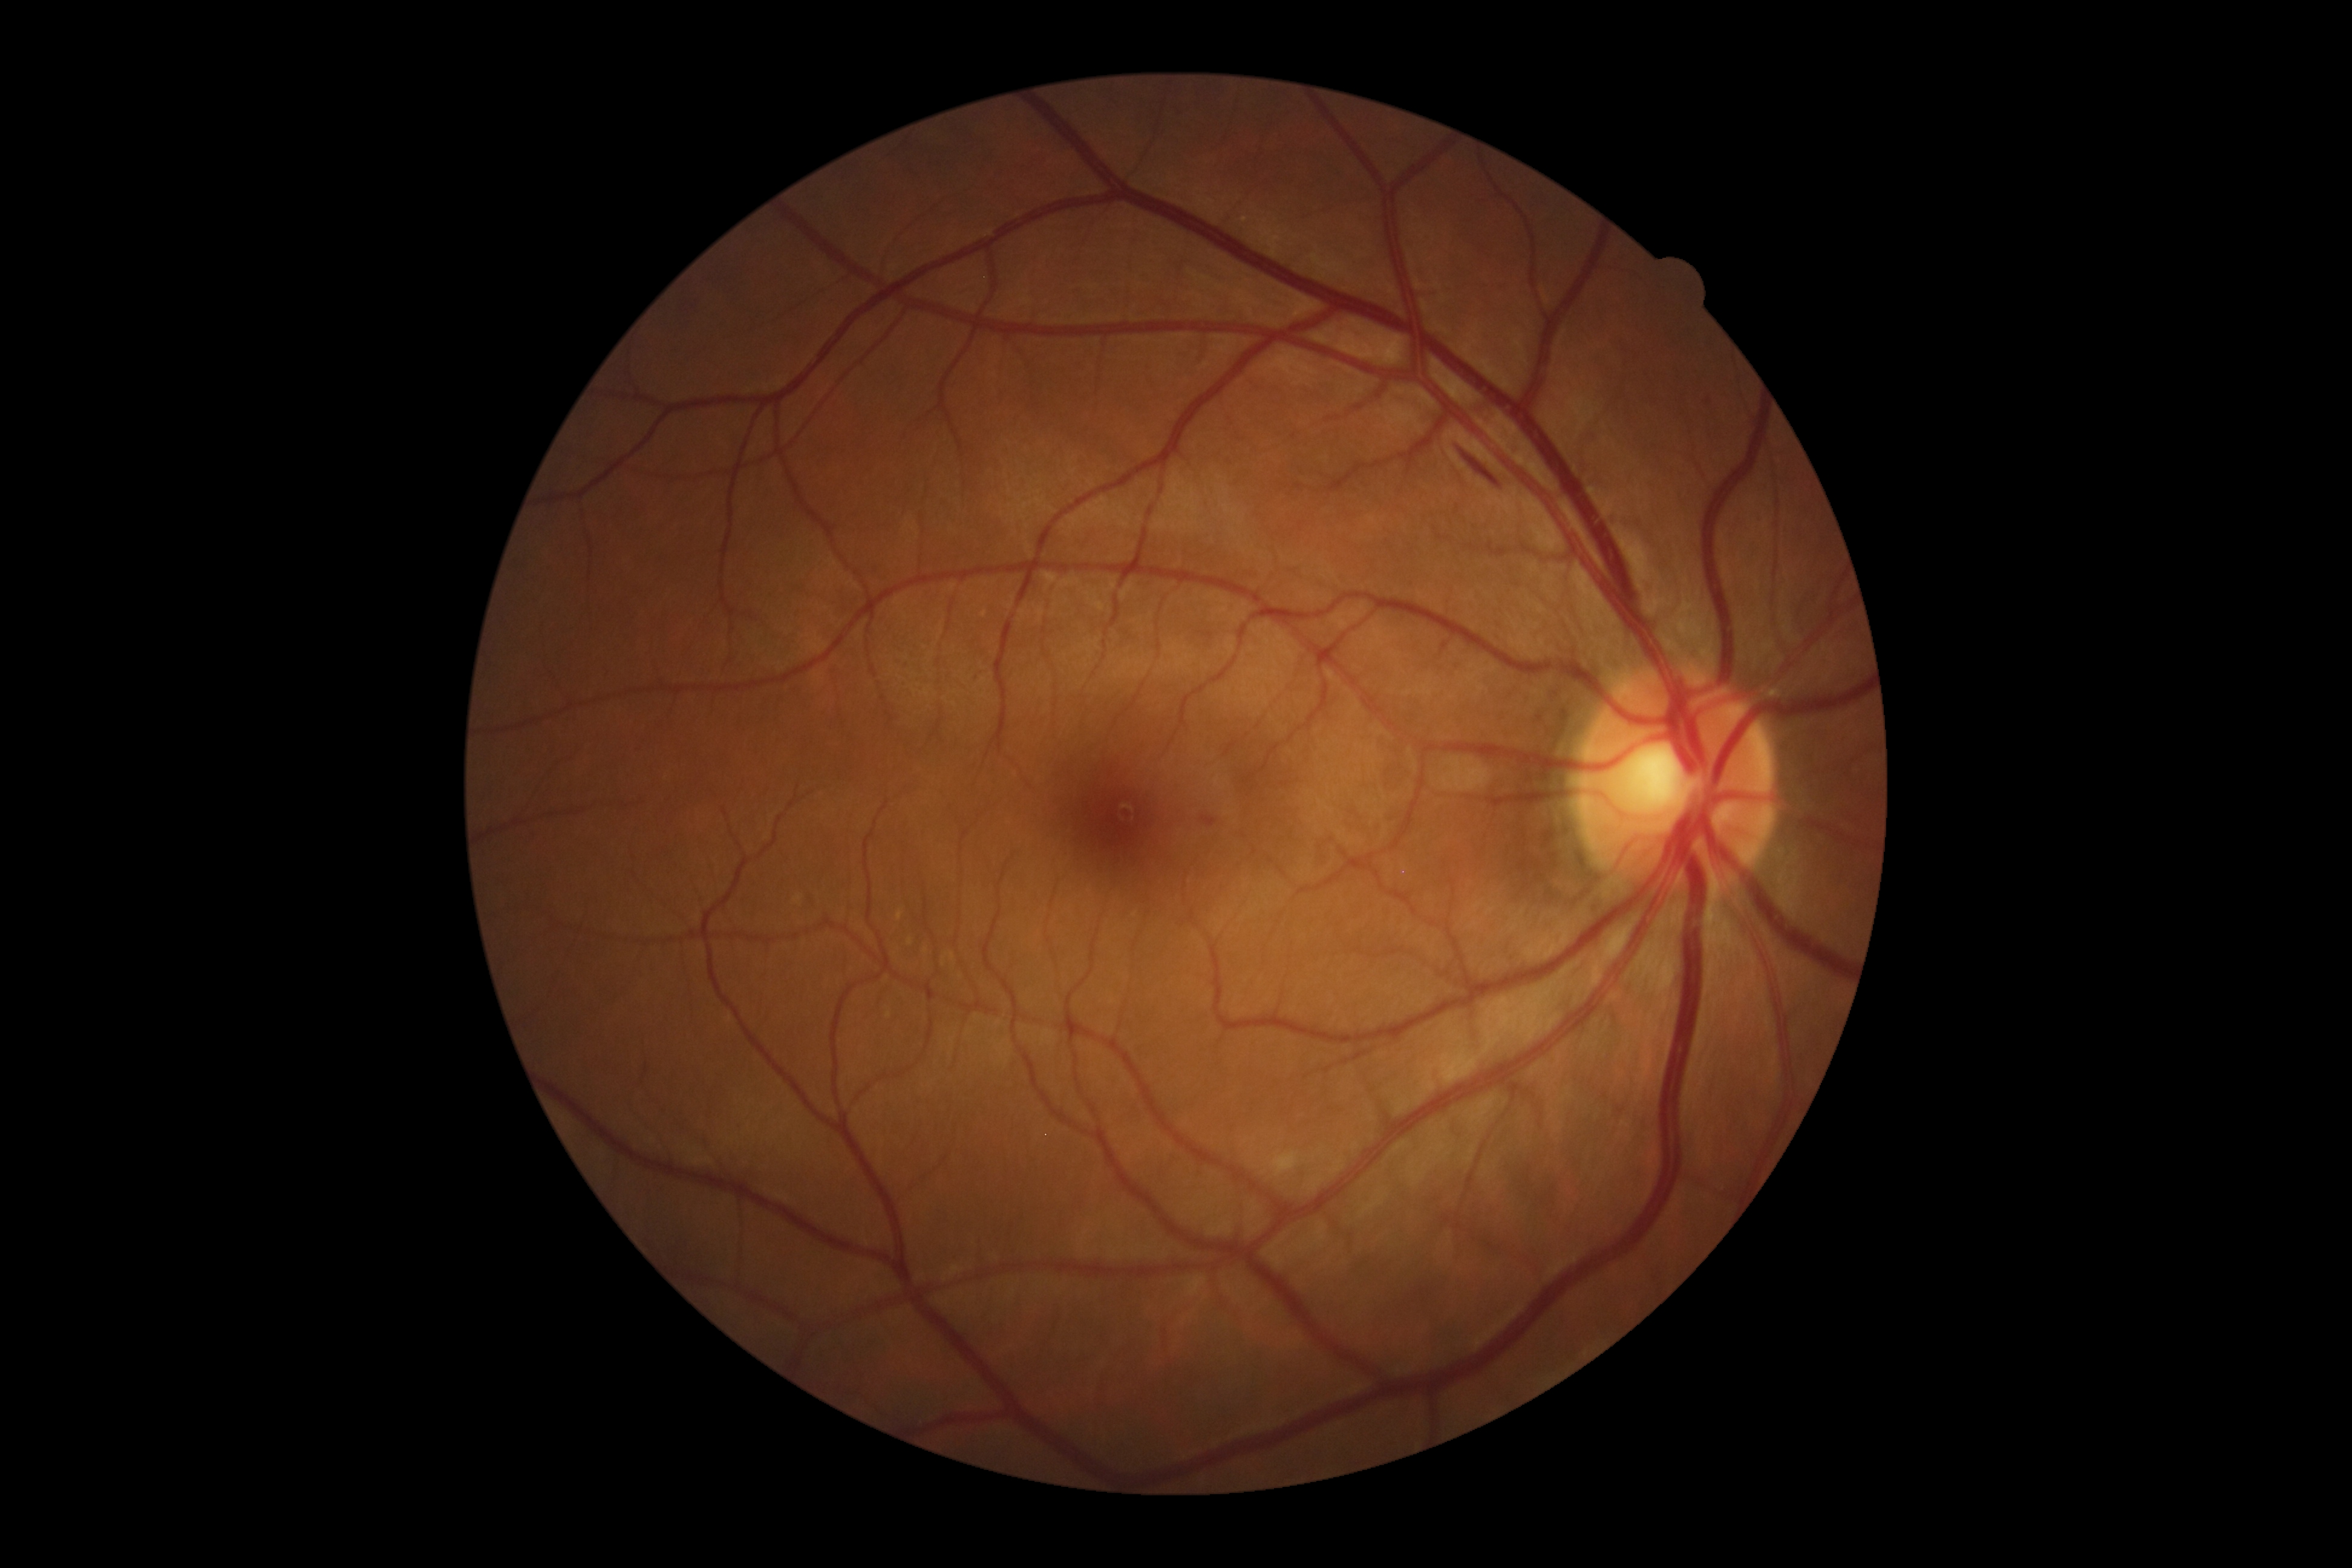 DR is moderate non-proliferative diabetic retinopathy (grade 2).